Infant wide-field fundus photograph: 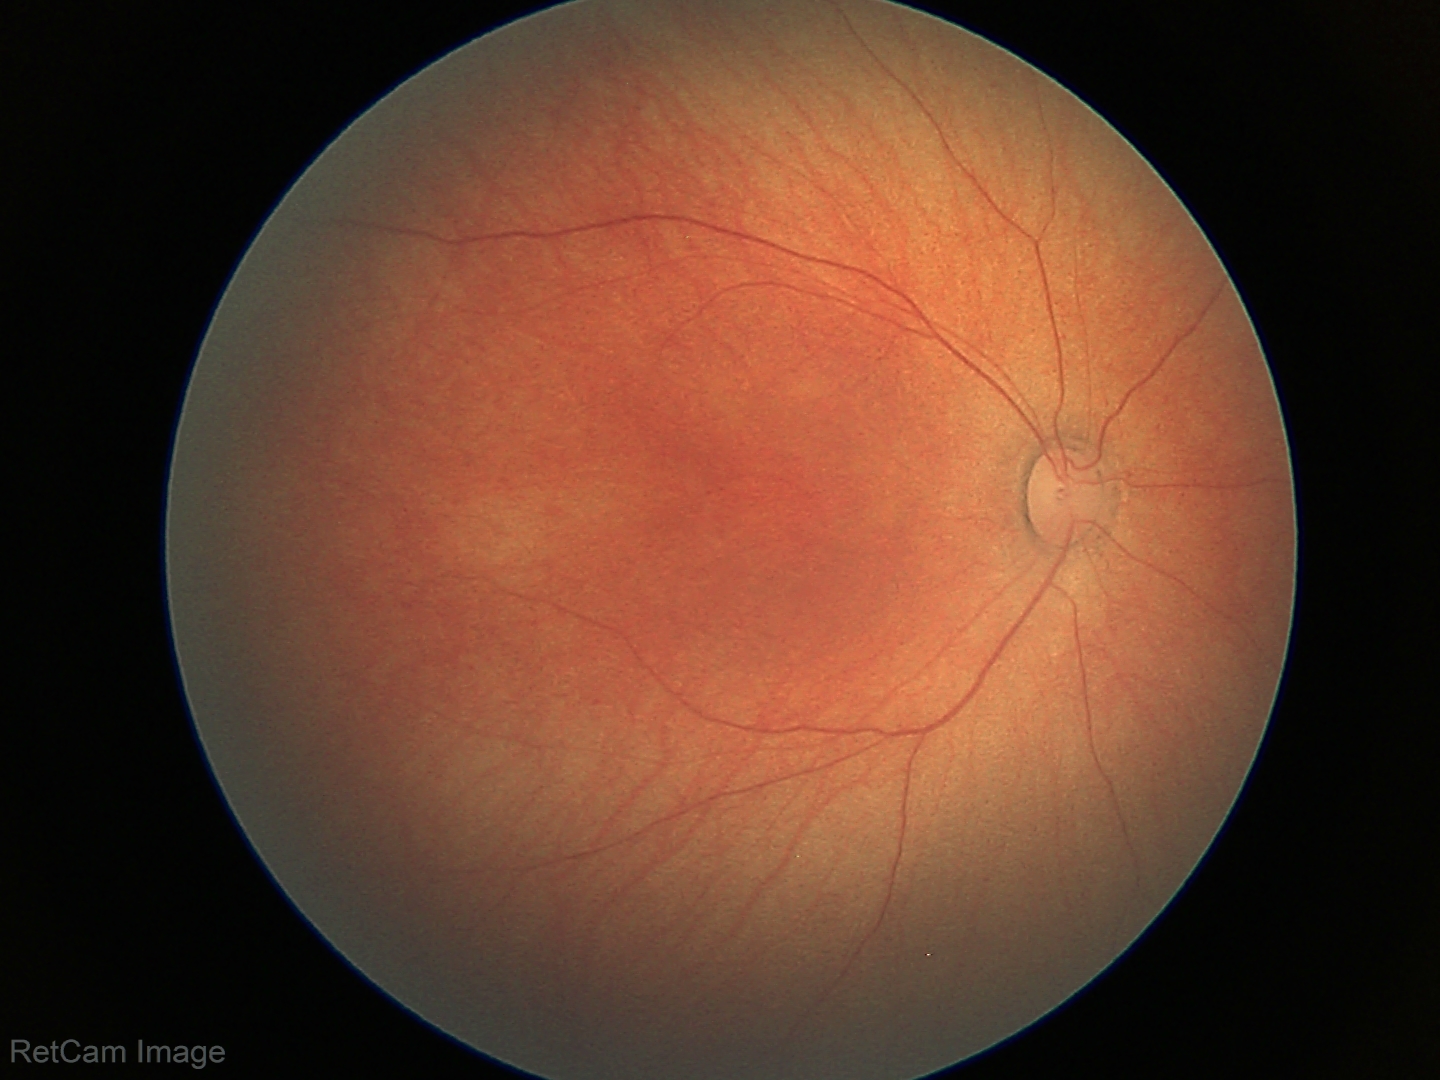
Assessment: normal retinal appearance